Color fundus photograph, 848x848px:
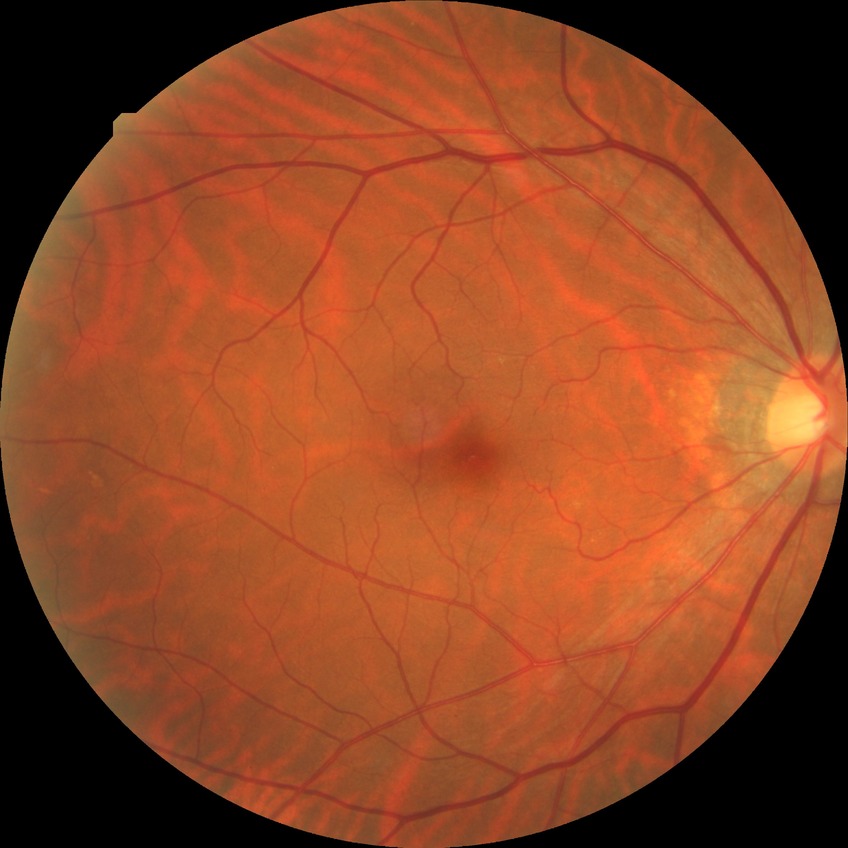
modified Davis grading: no diabetic retinopathy.